Modified Davis grading — 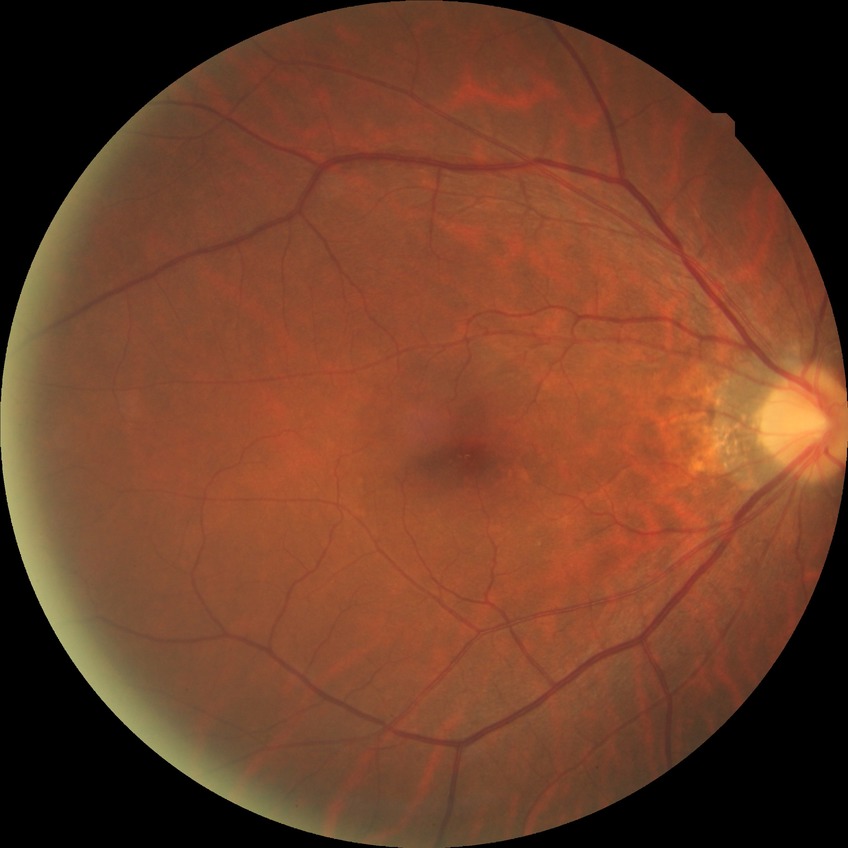

Retinopathy grade is no diabetic retinopathy.